2352 x 1568 pixels · FOV: 45 degrees.
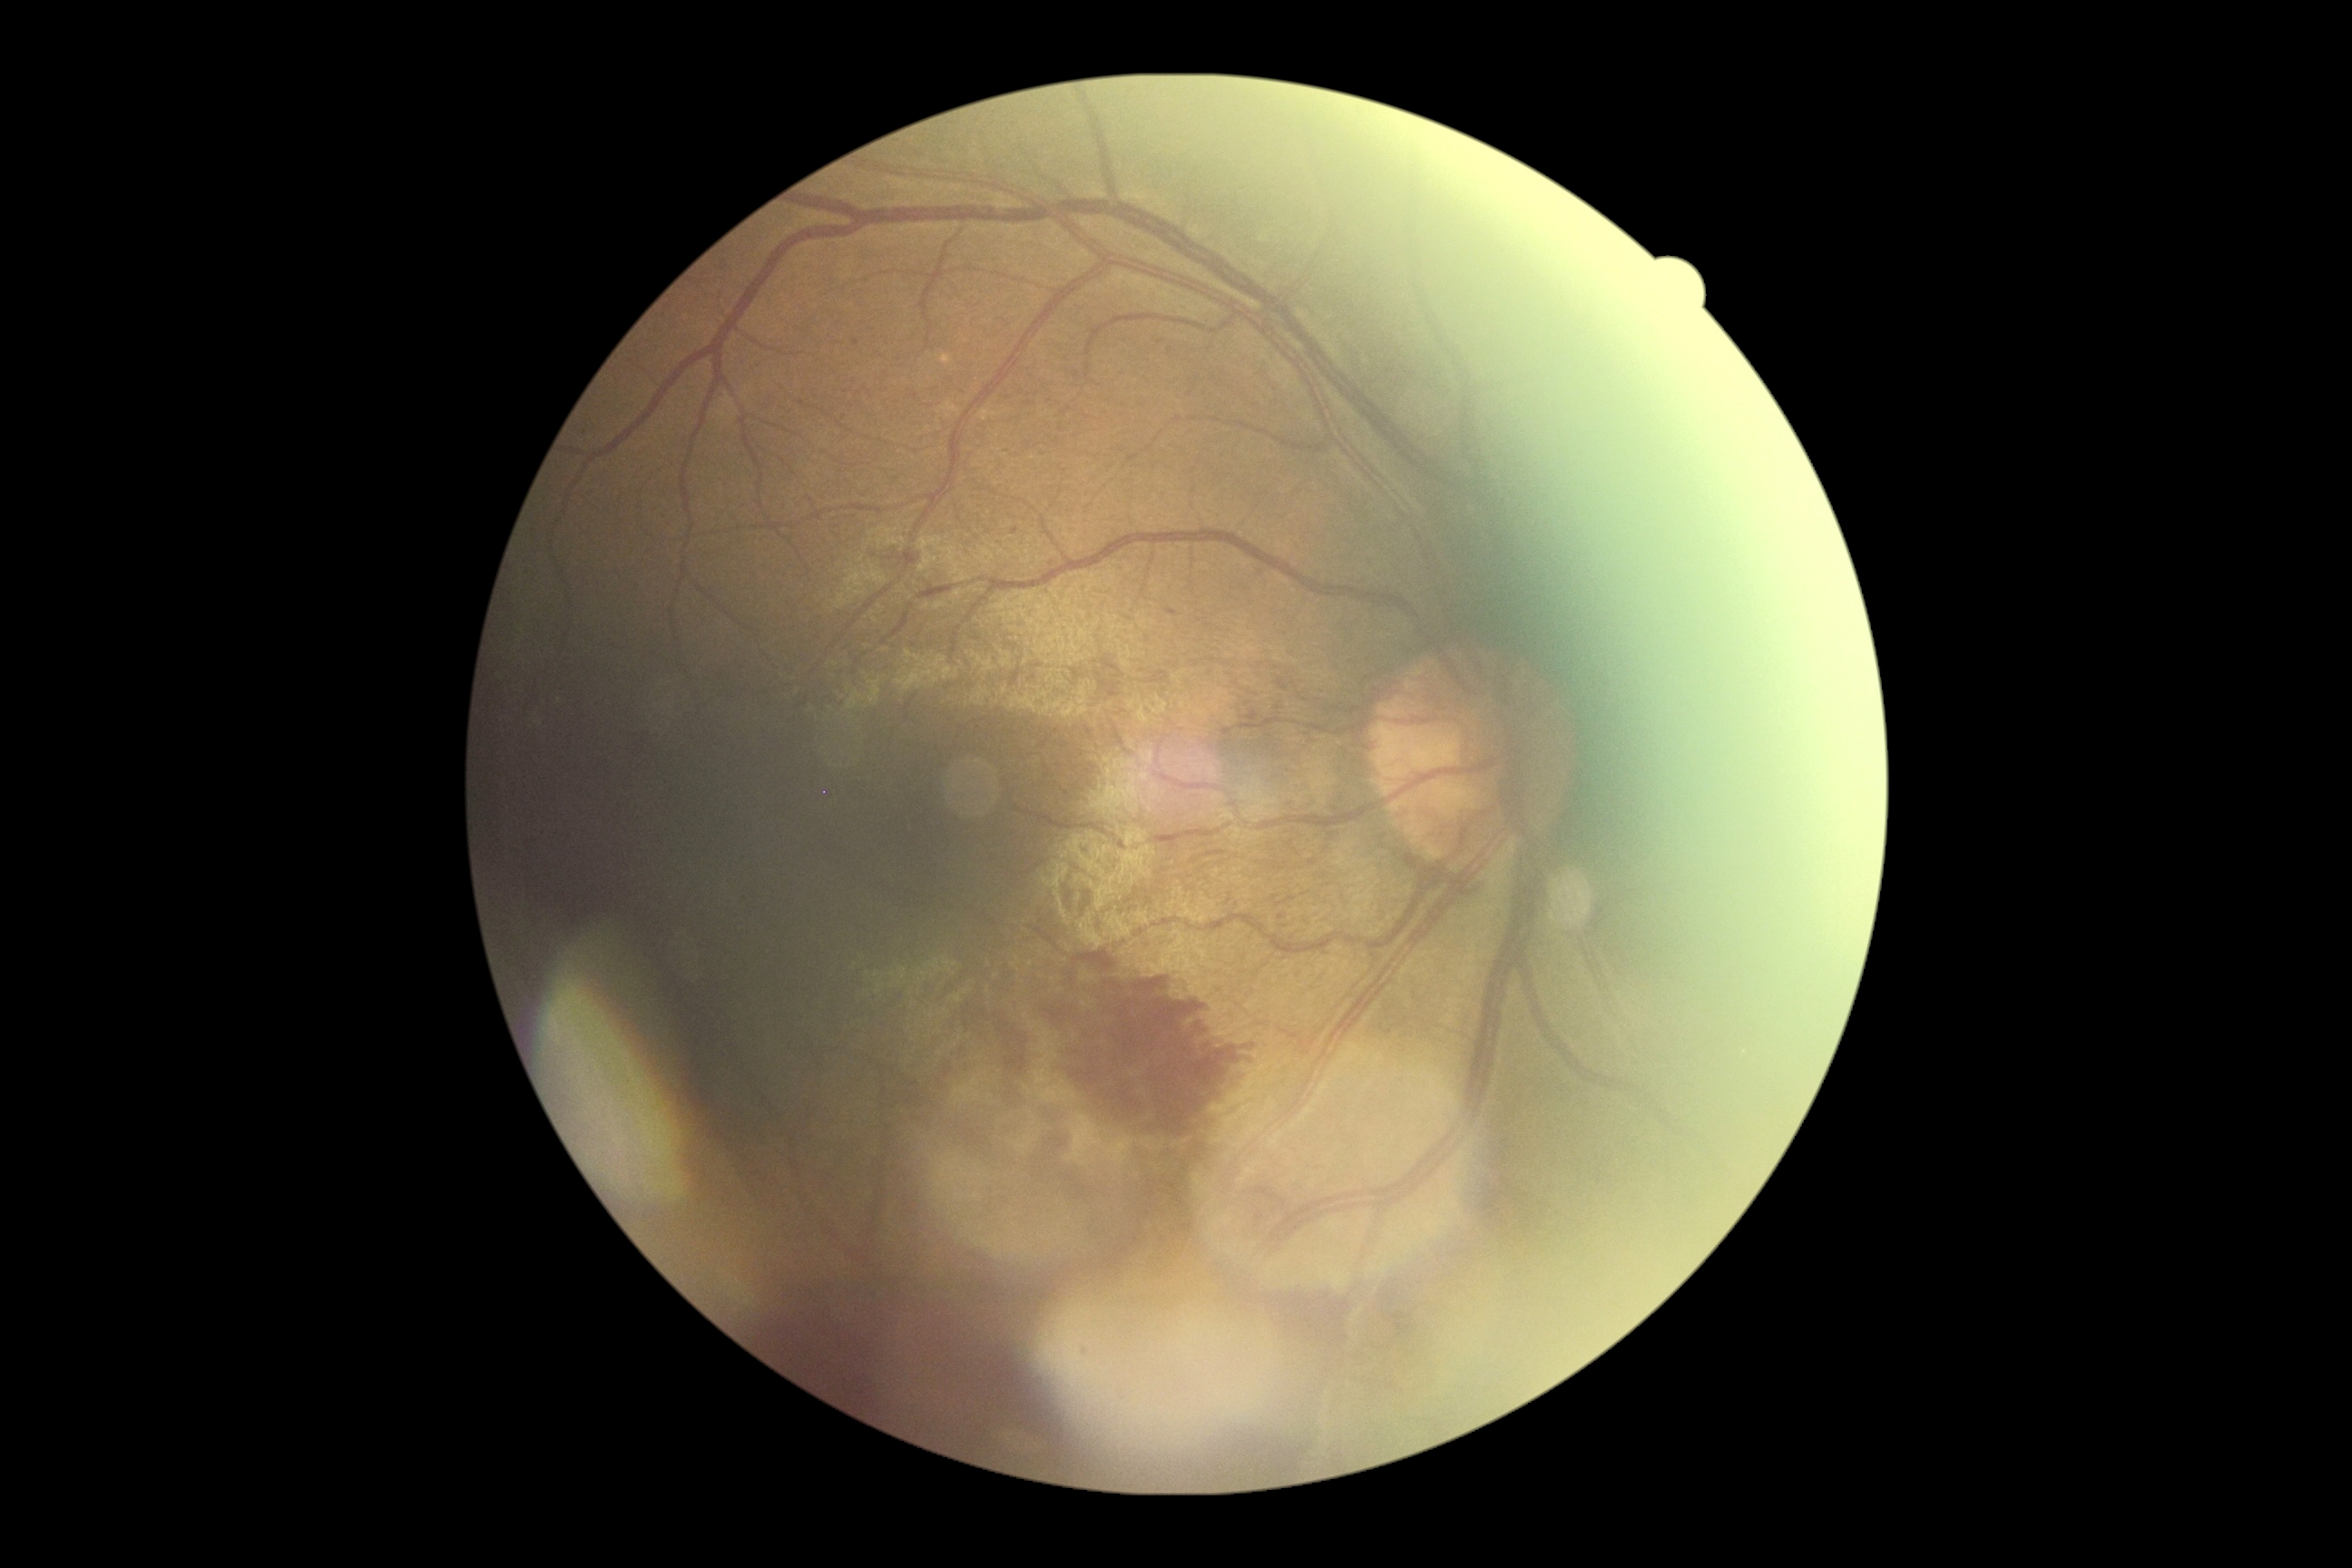
The retinopathy is classified as proliferative diabetic retinopathy. Diabetic retinopathy grade: 4.